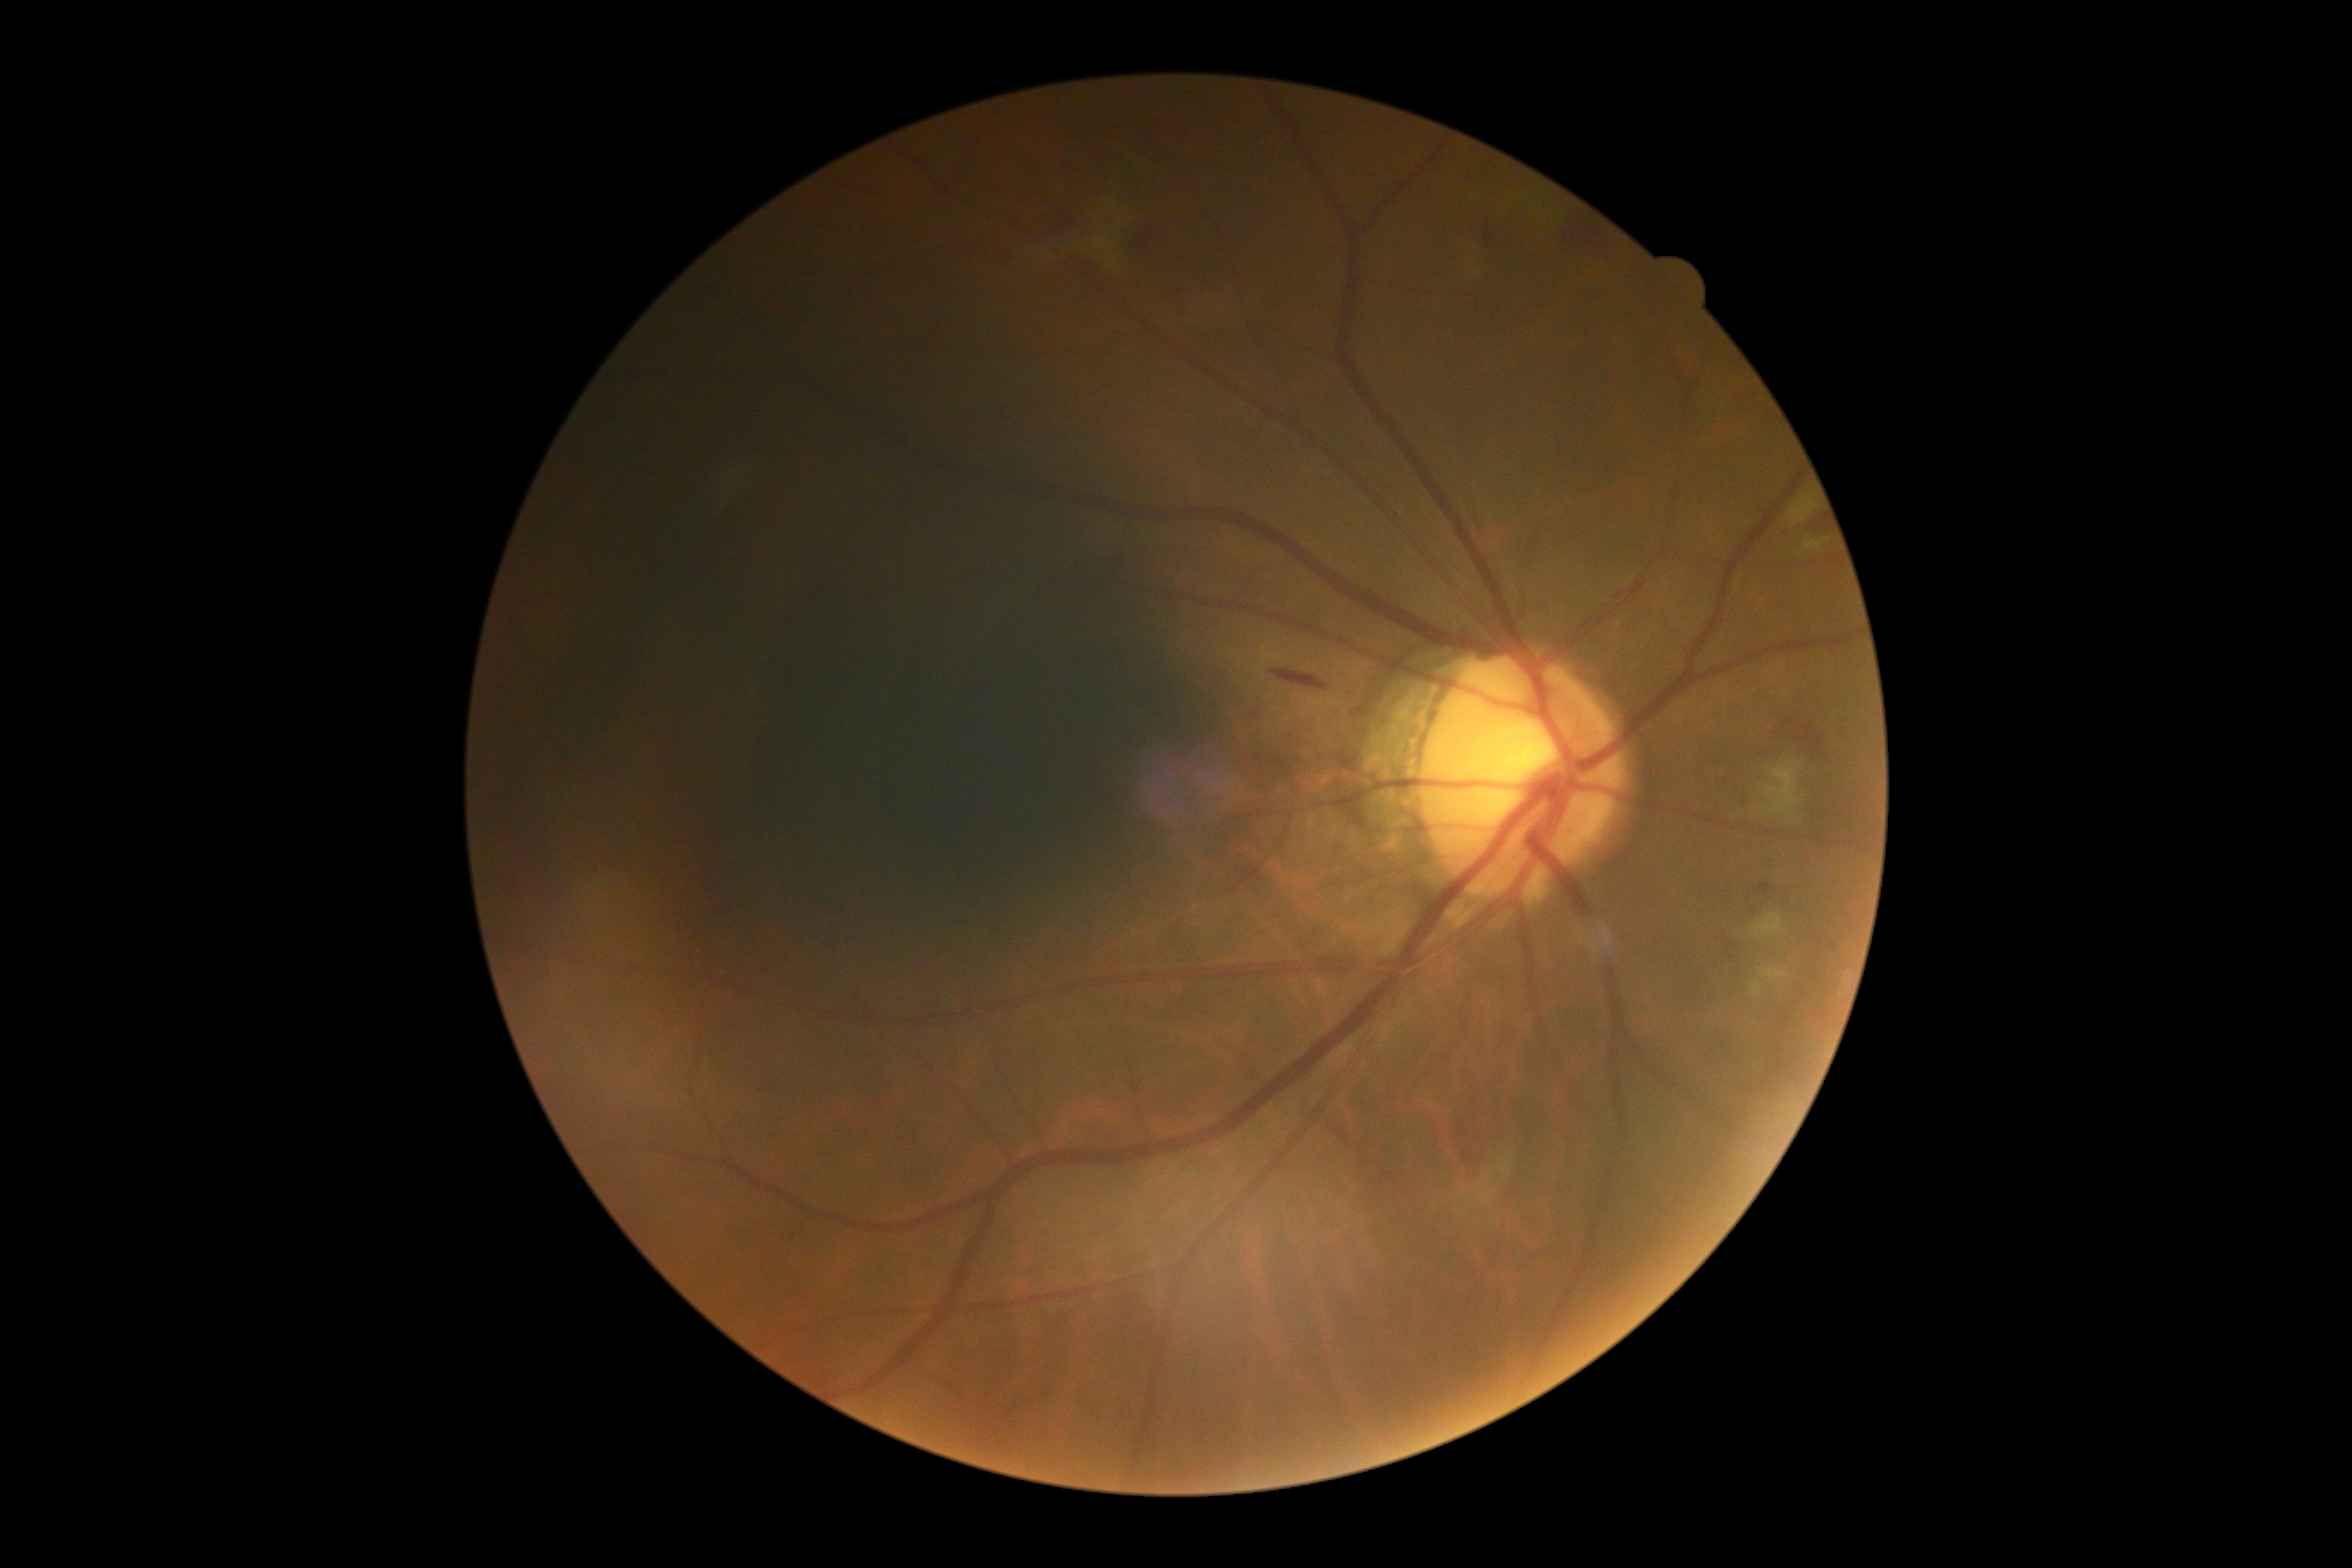
Retinopathy grade is 2 (moderate NPDR).